Diabetic retinopathy graded by the modified Davis classification
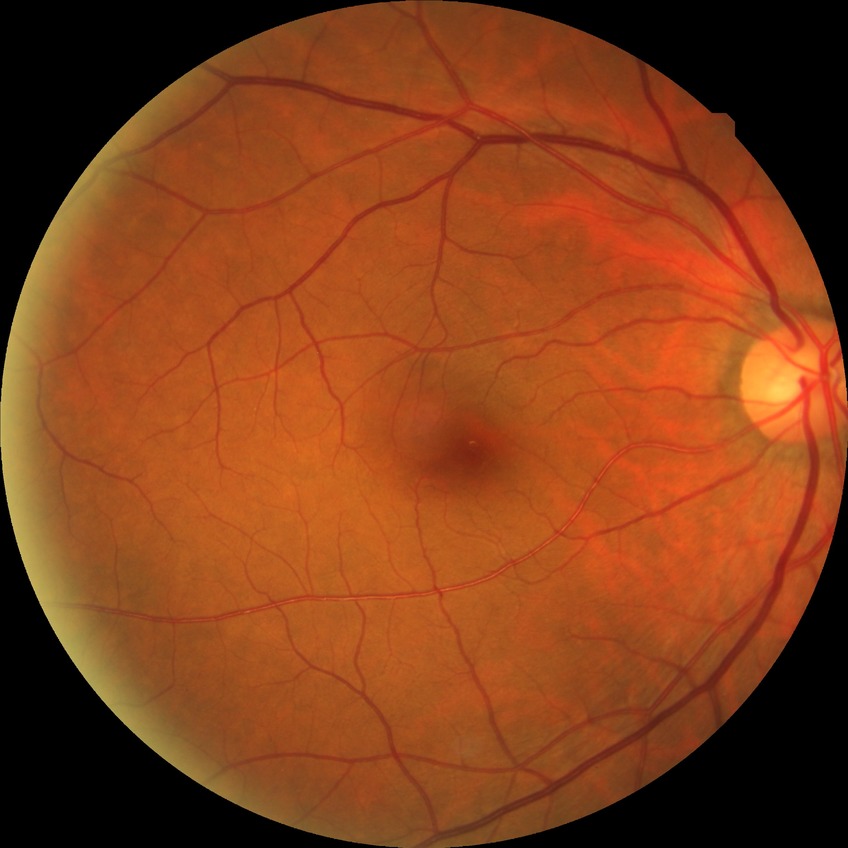

Diabetic retinopathy severity: no diabetic retinopathy.